2048 x 1536 pixels: 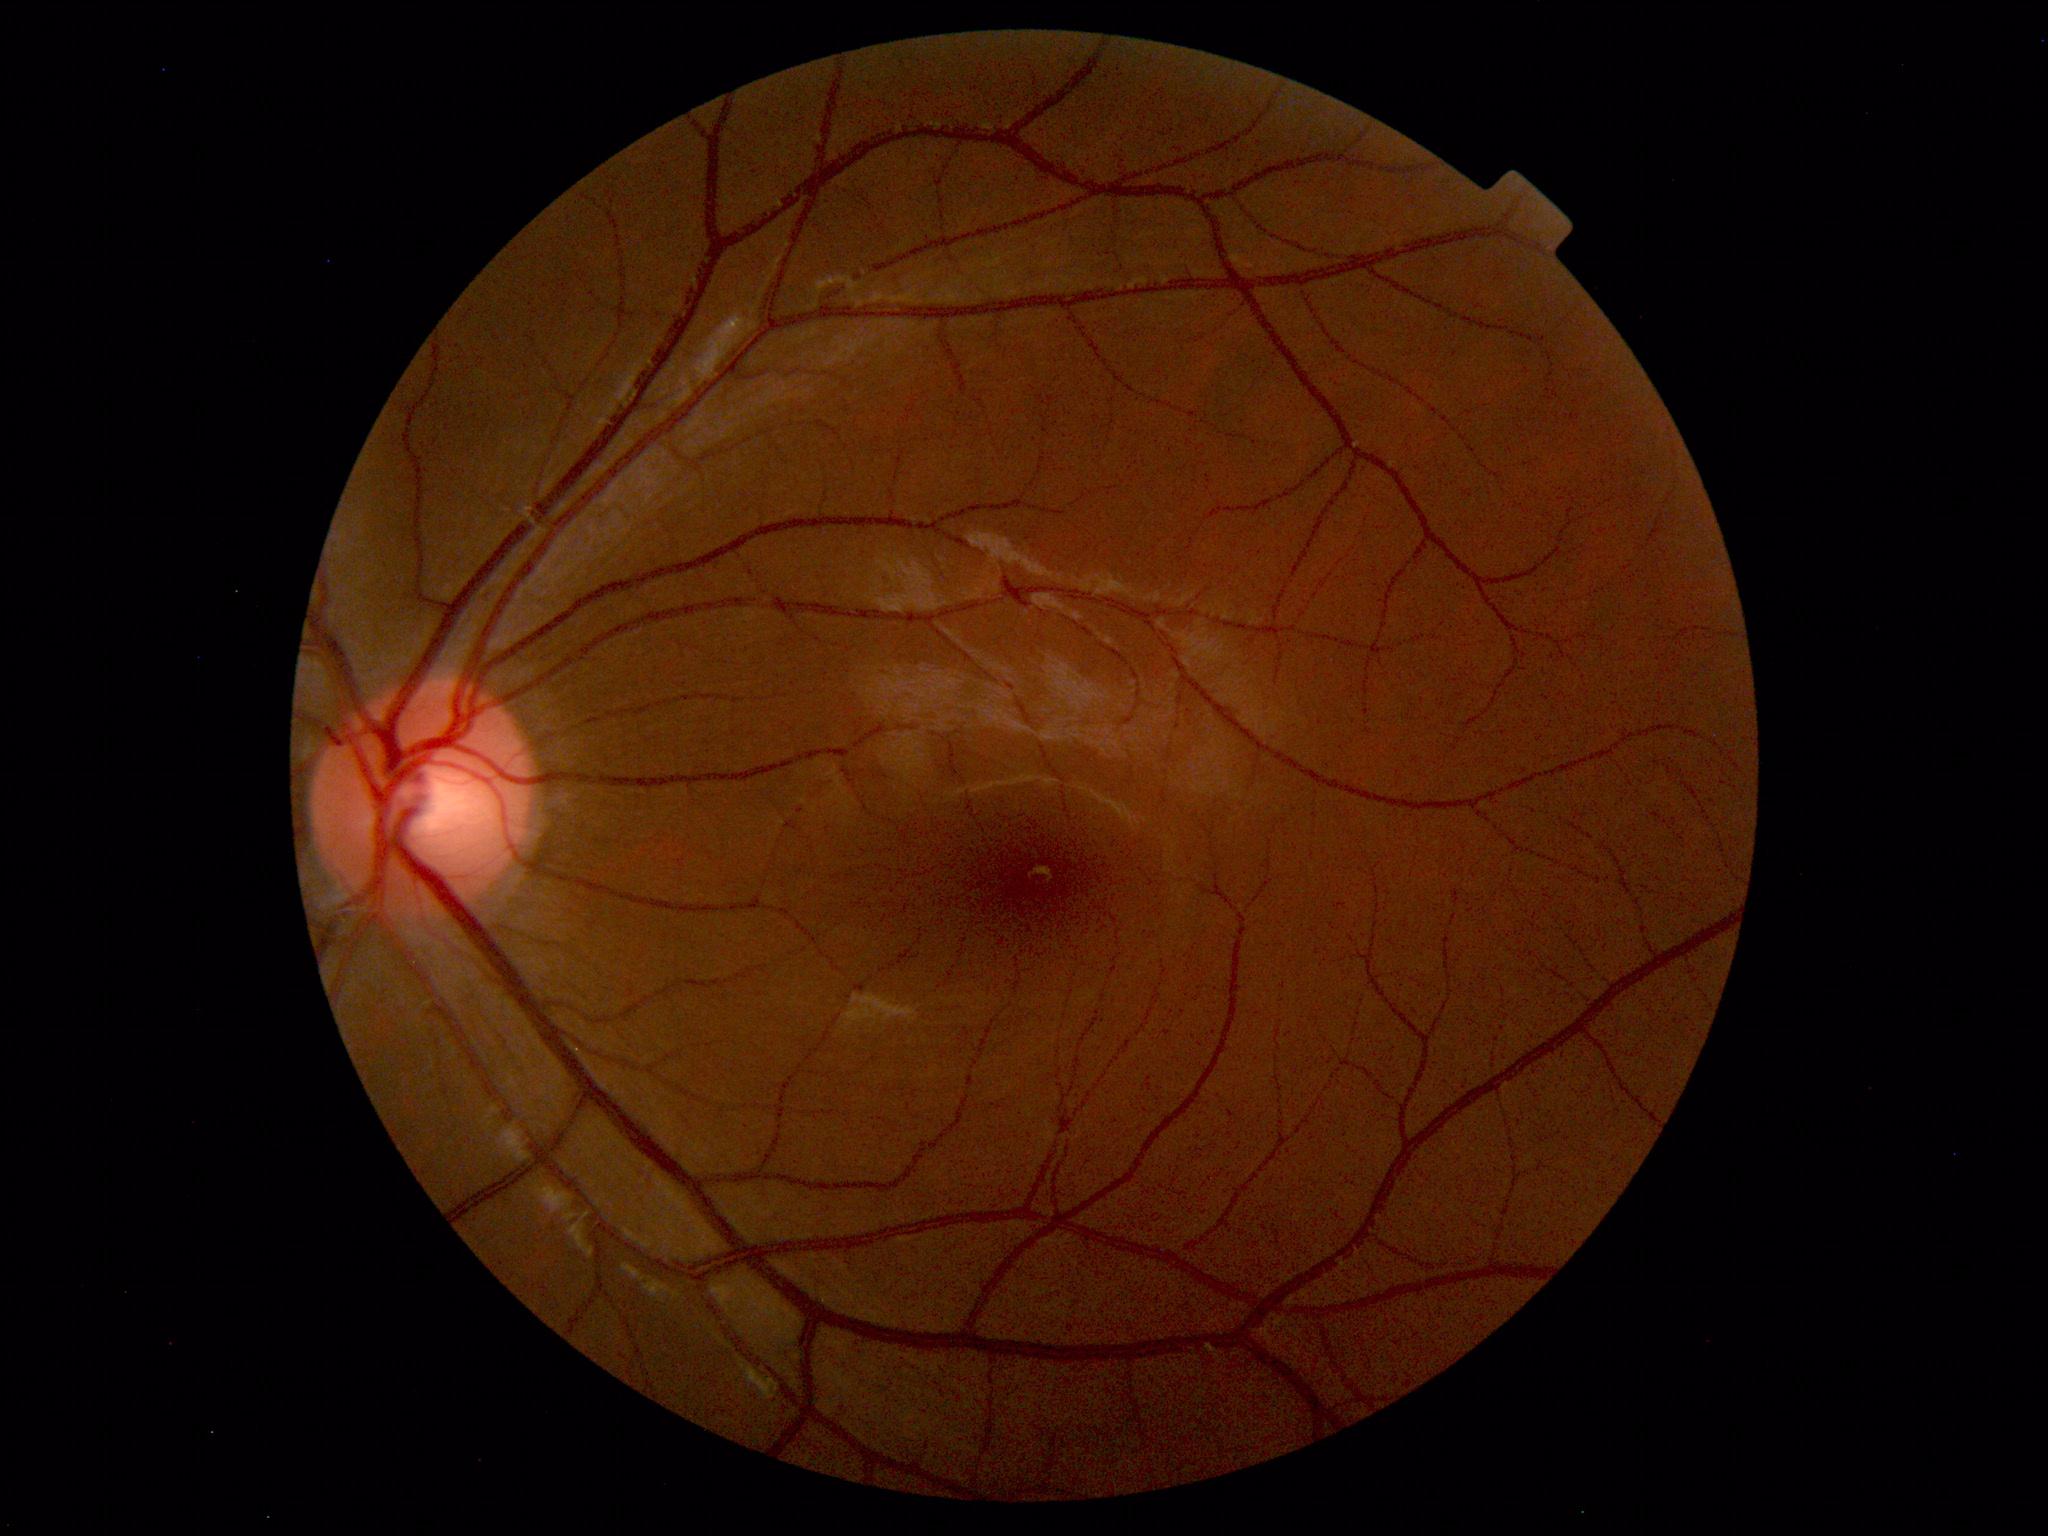 Normal fundus. No pathology identified.